Wide-field contact fundus photograph of an infant · acquired on the Clarity RetCam 3 · 640 by 480 pixels.
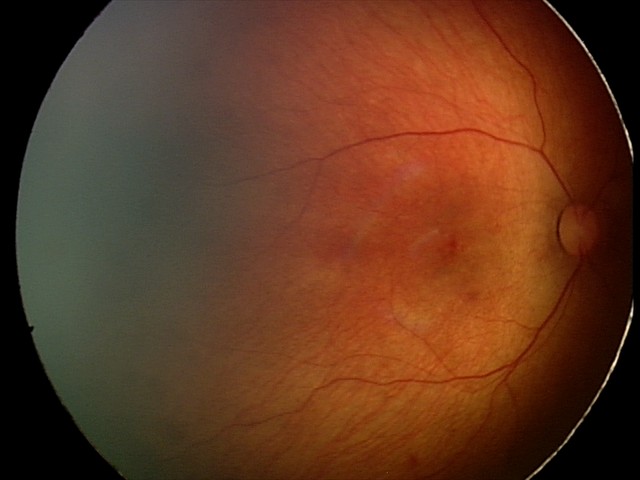 Screening series with retinal hemorrhages.